NIDEK AFC-230, 45° FOV:
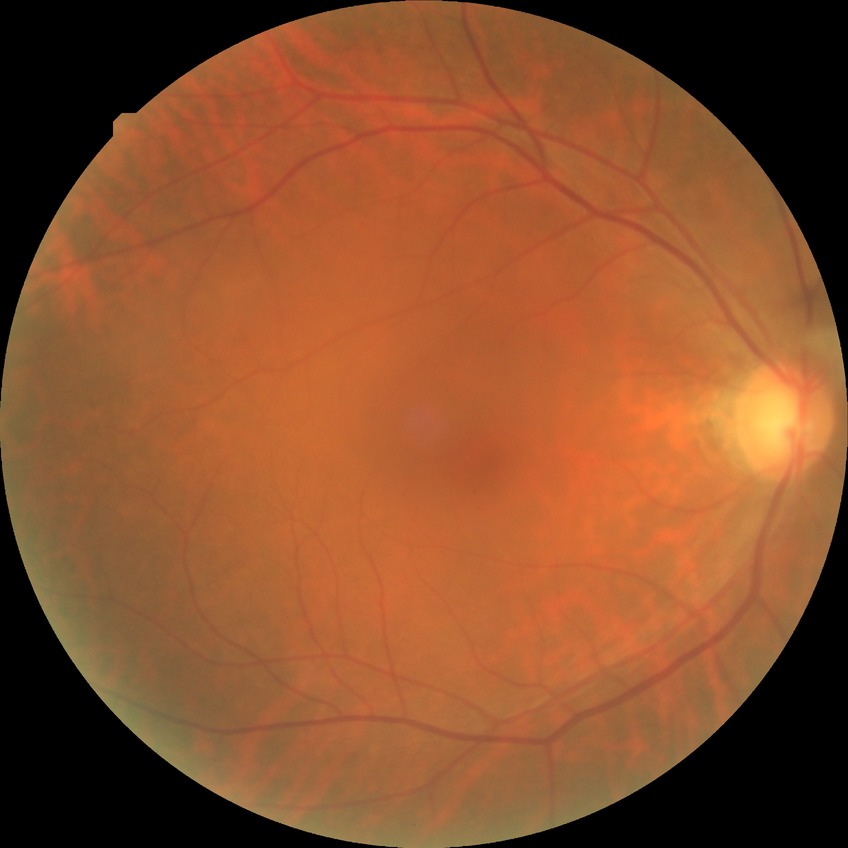 Assessment:
• DR impression: no DR findings
• DR: NDR